45° field of view.
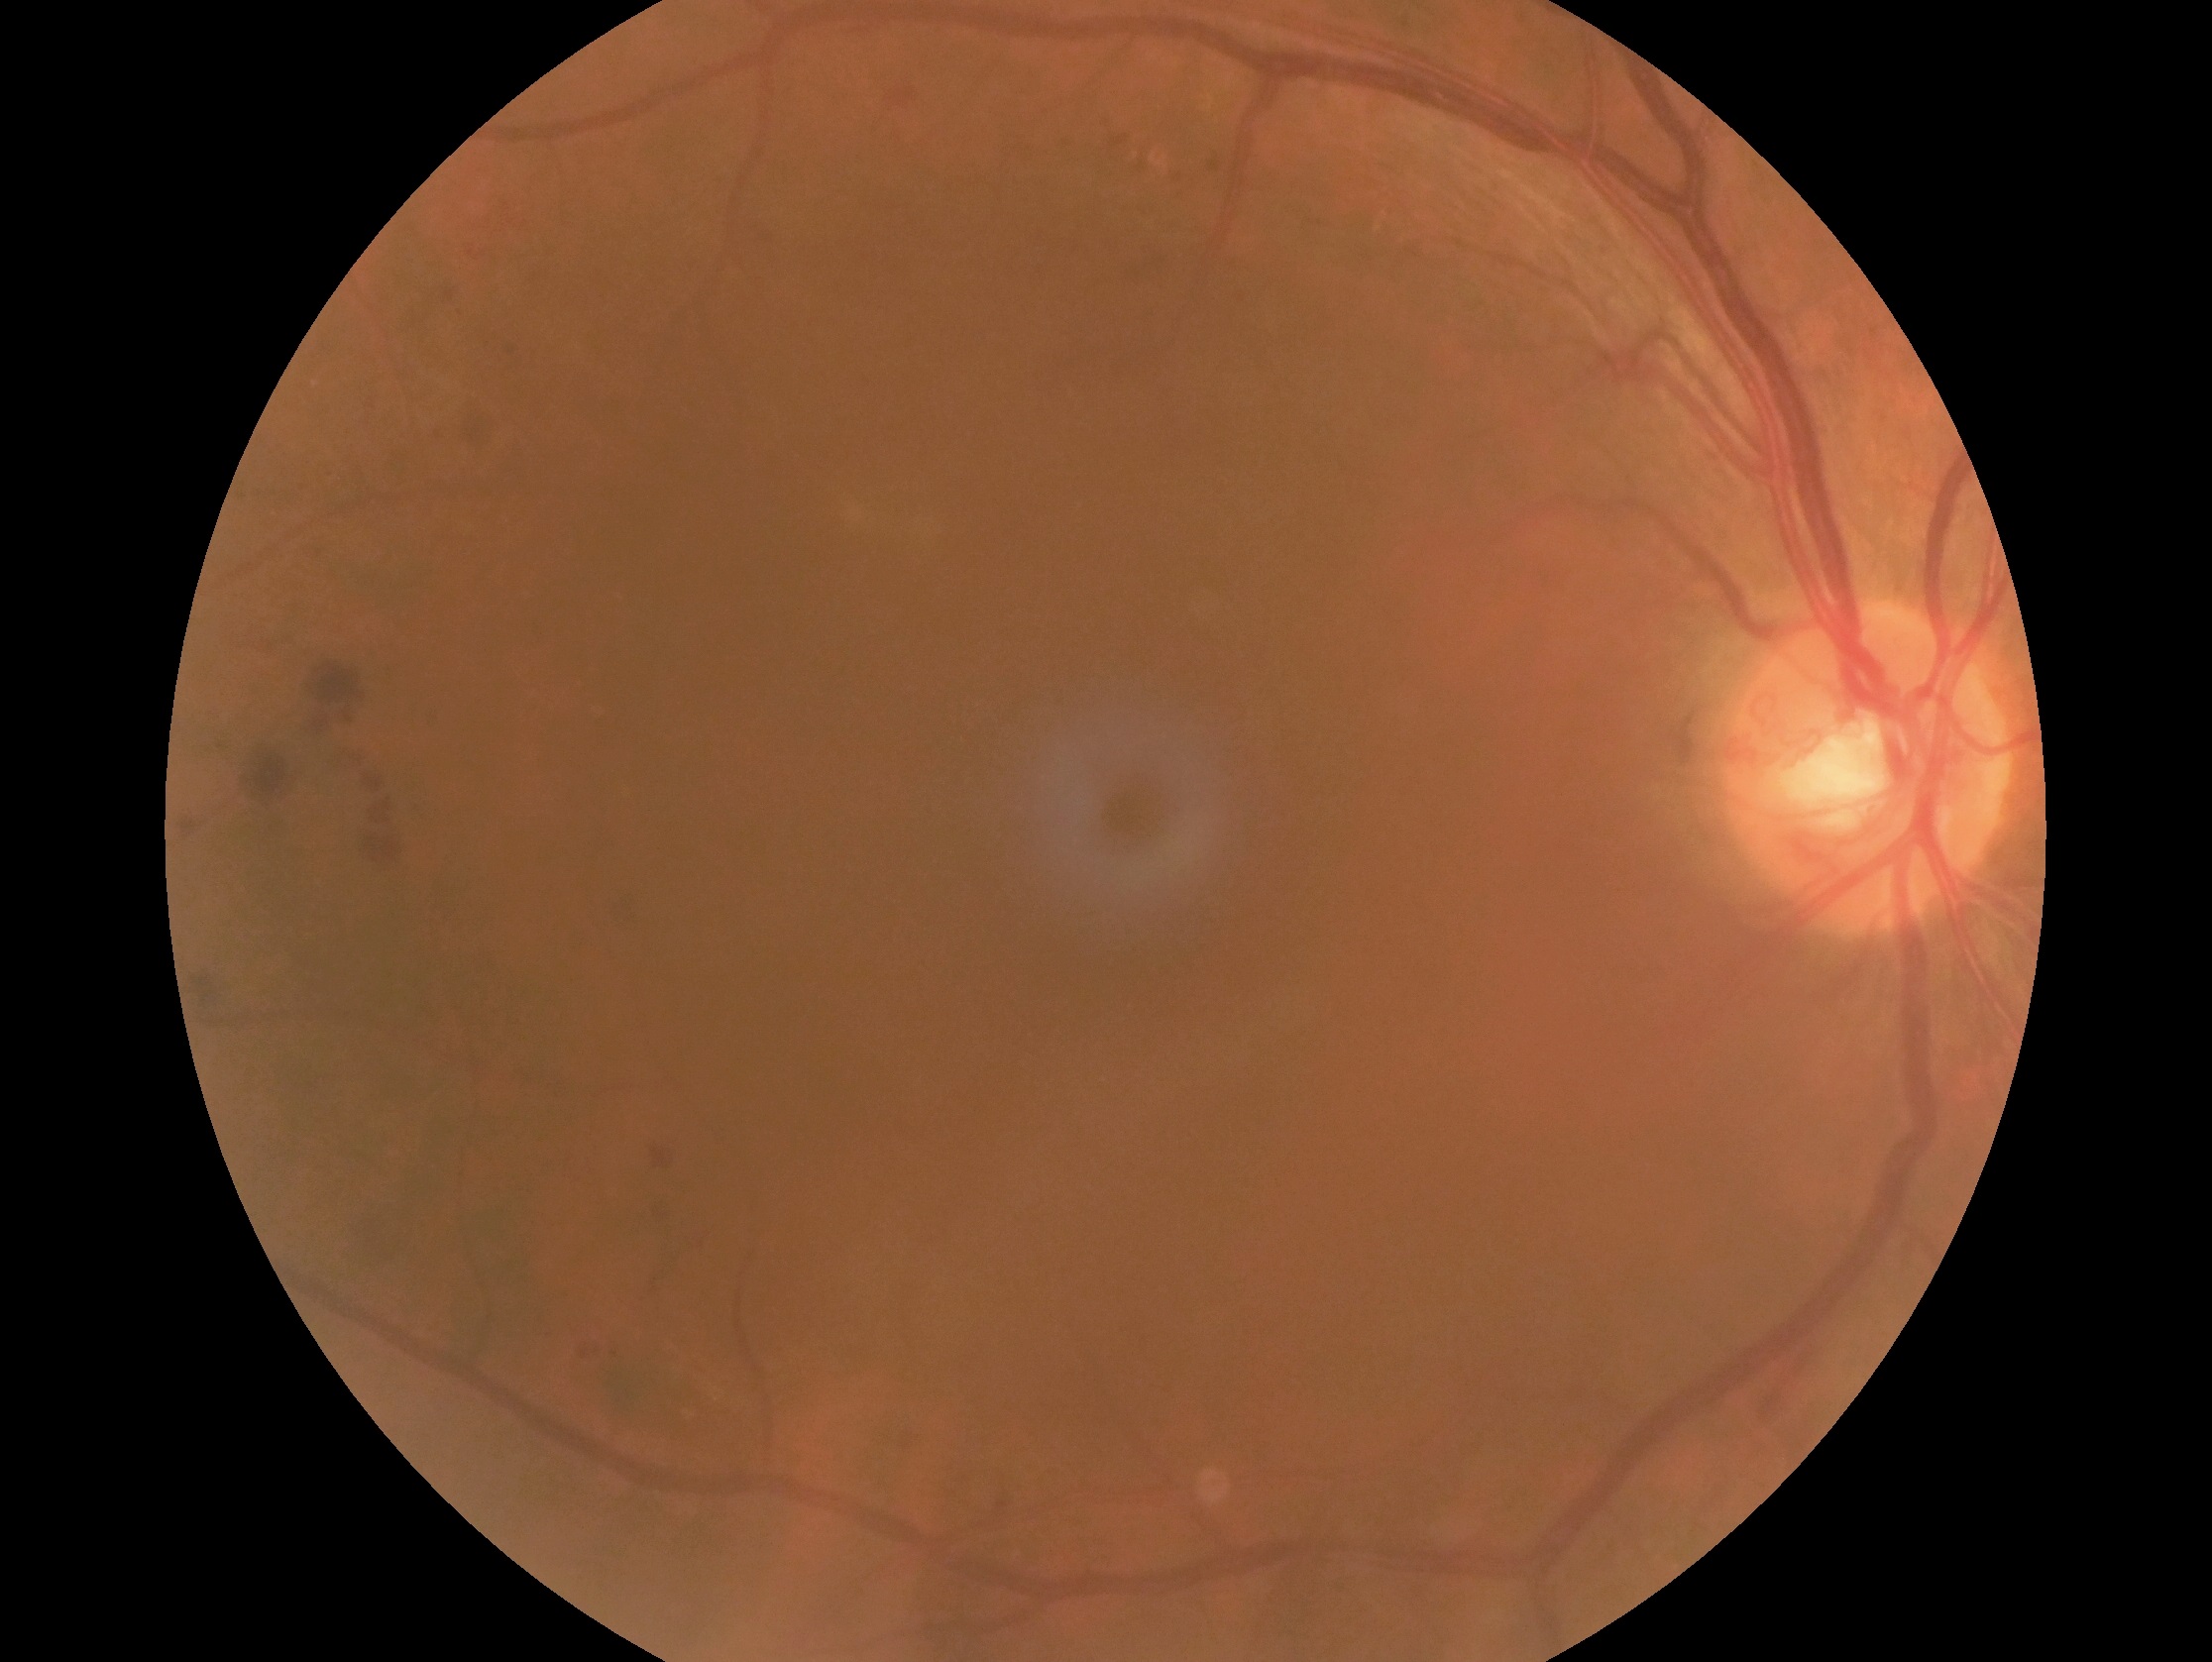

Annotations:
* diabetic retinopathy severity — grade 4 (PDR)
* DR class — proliferative diabetic retinopathy